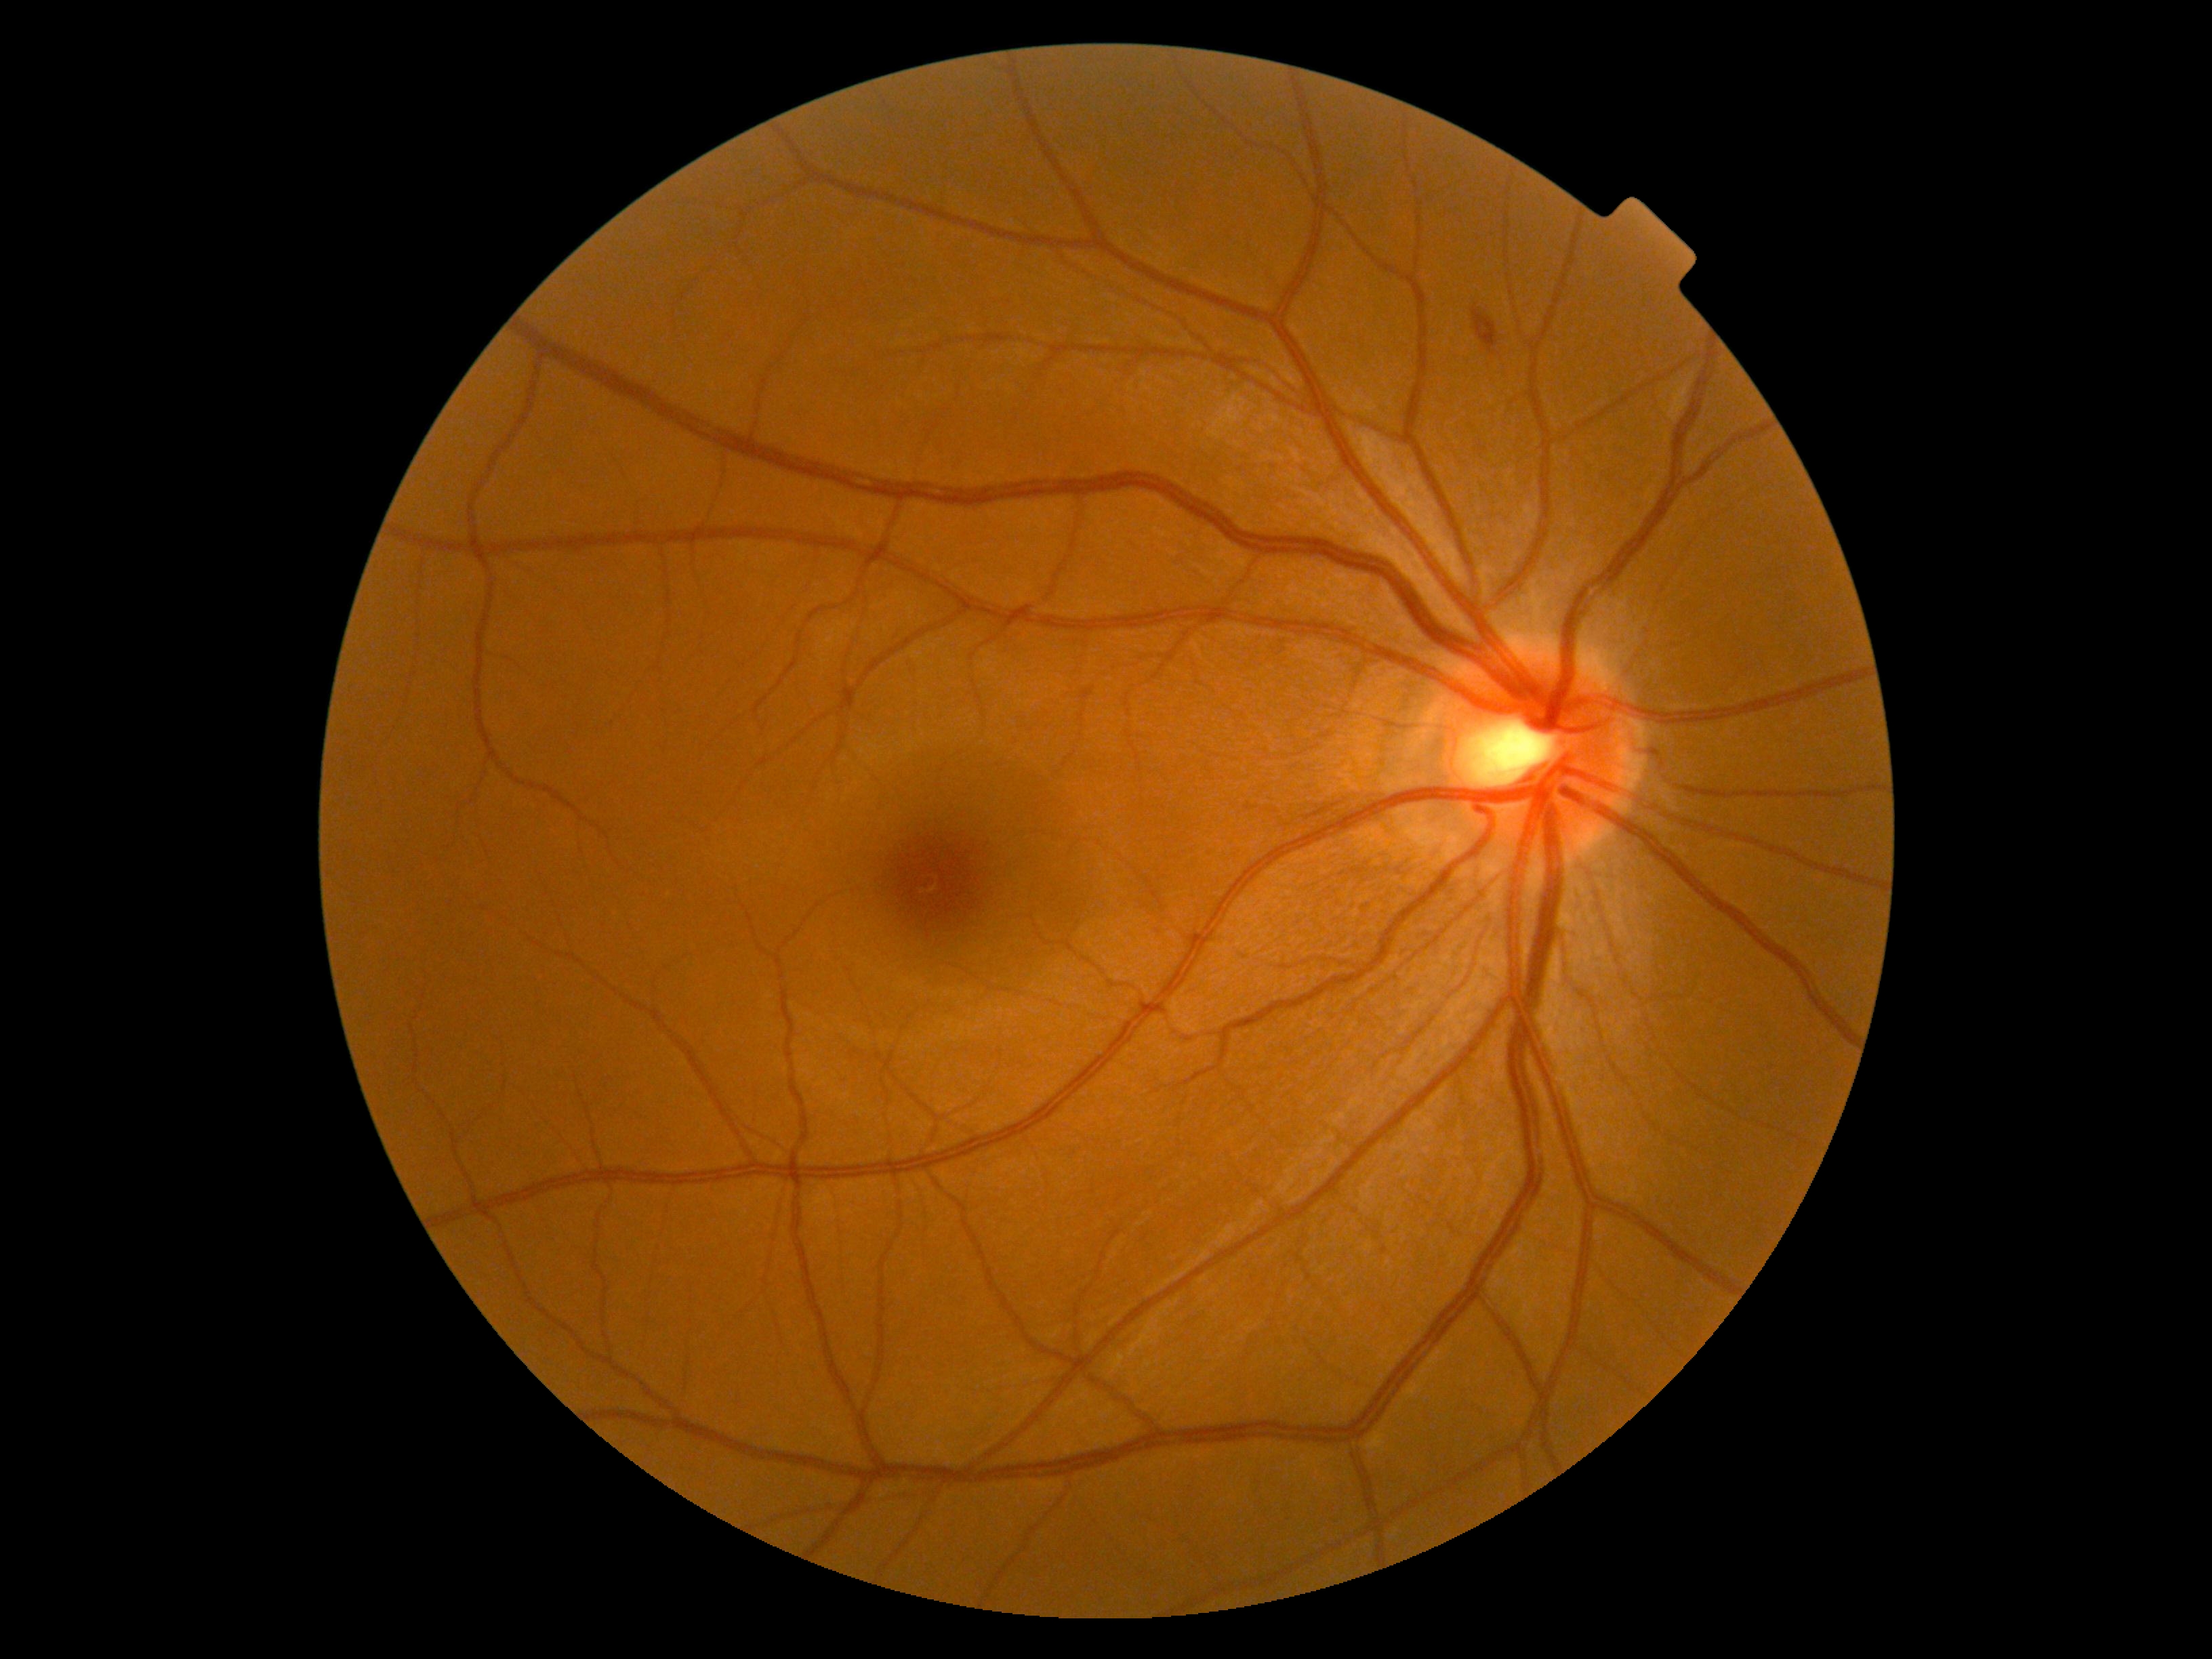

Diabetic retinopathy (DR): moderate NPDR (grade 2).